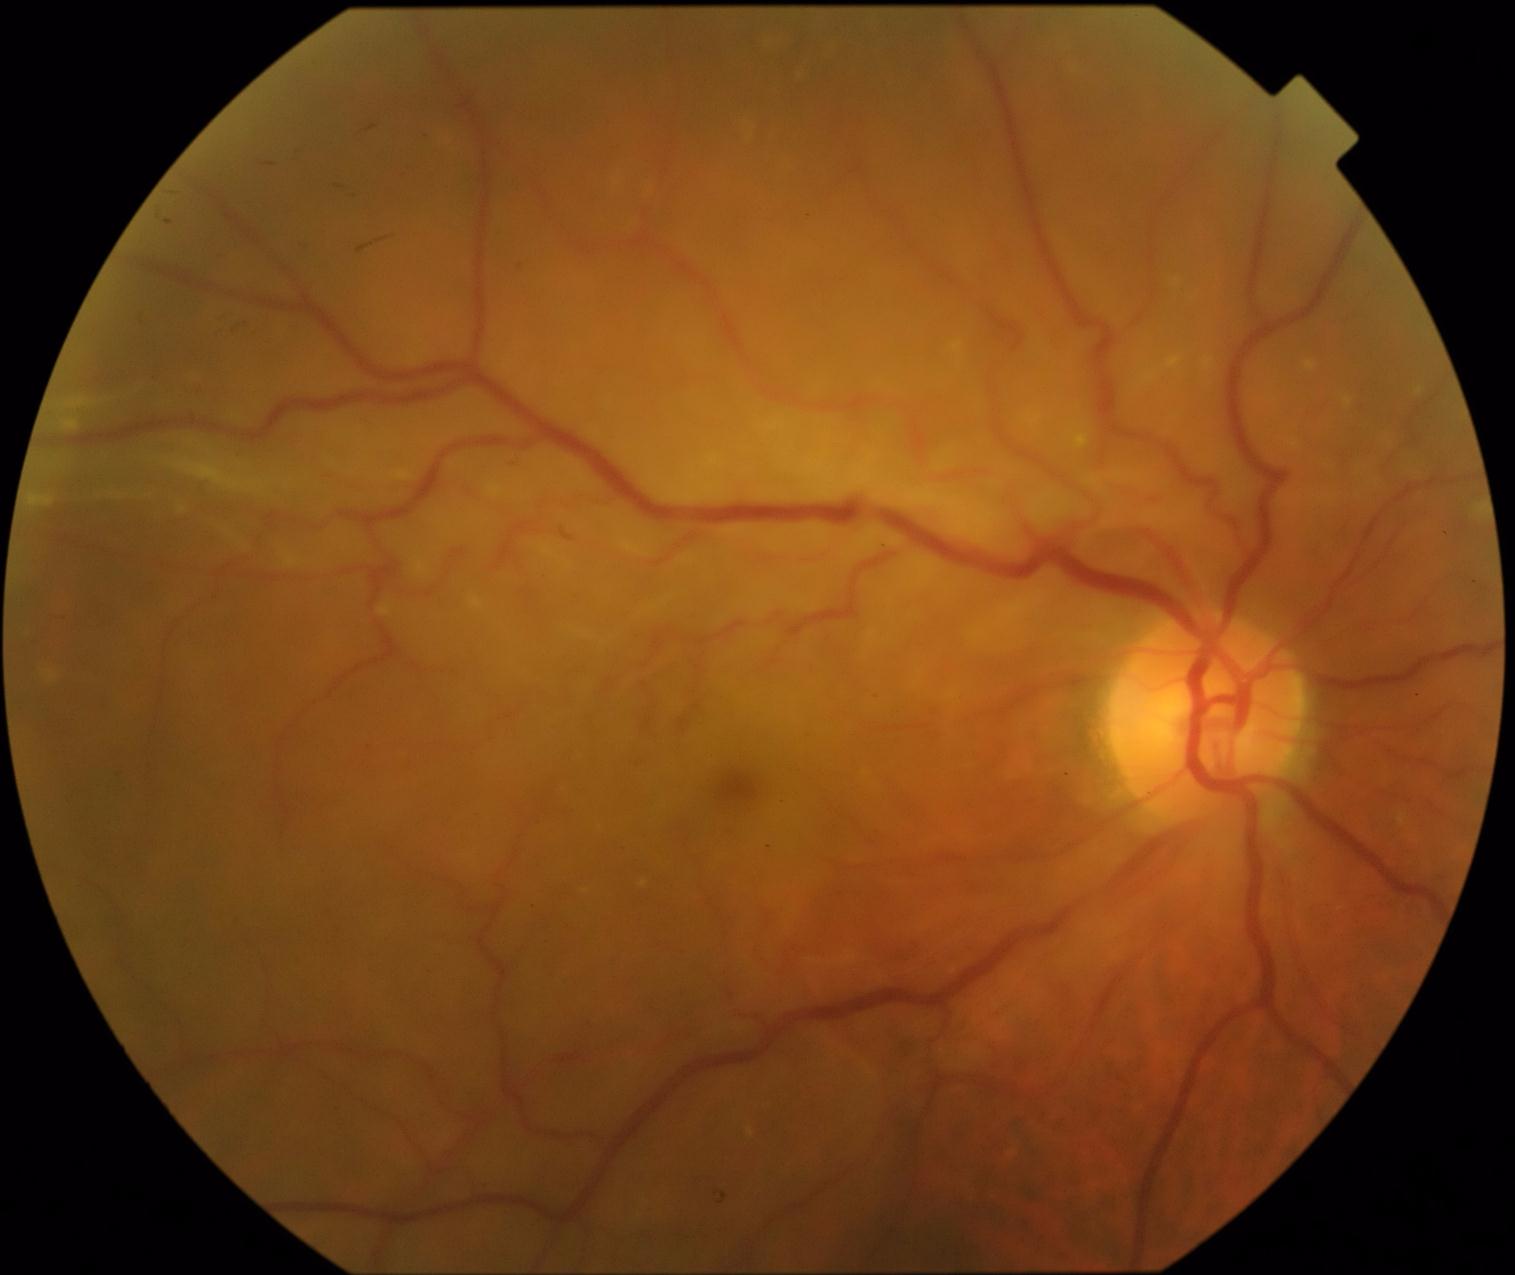

The retinopathy is classified as proliferative diabetic retinopathy. DR severity: grade 4.